45° field of view; 2212x1659; fundus photo
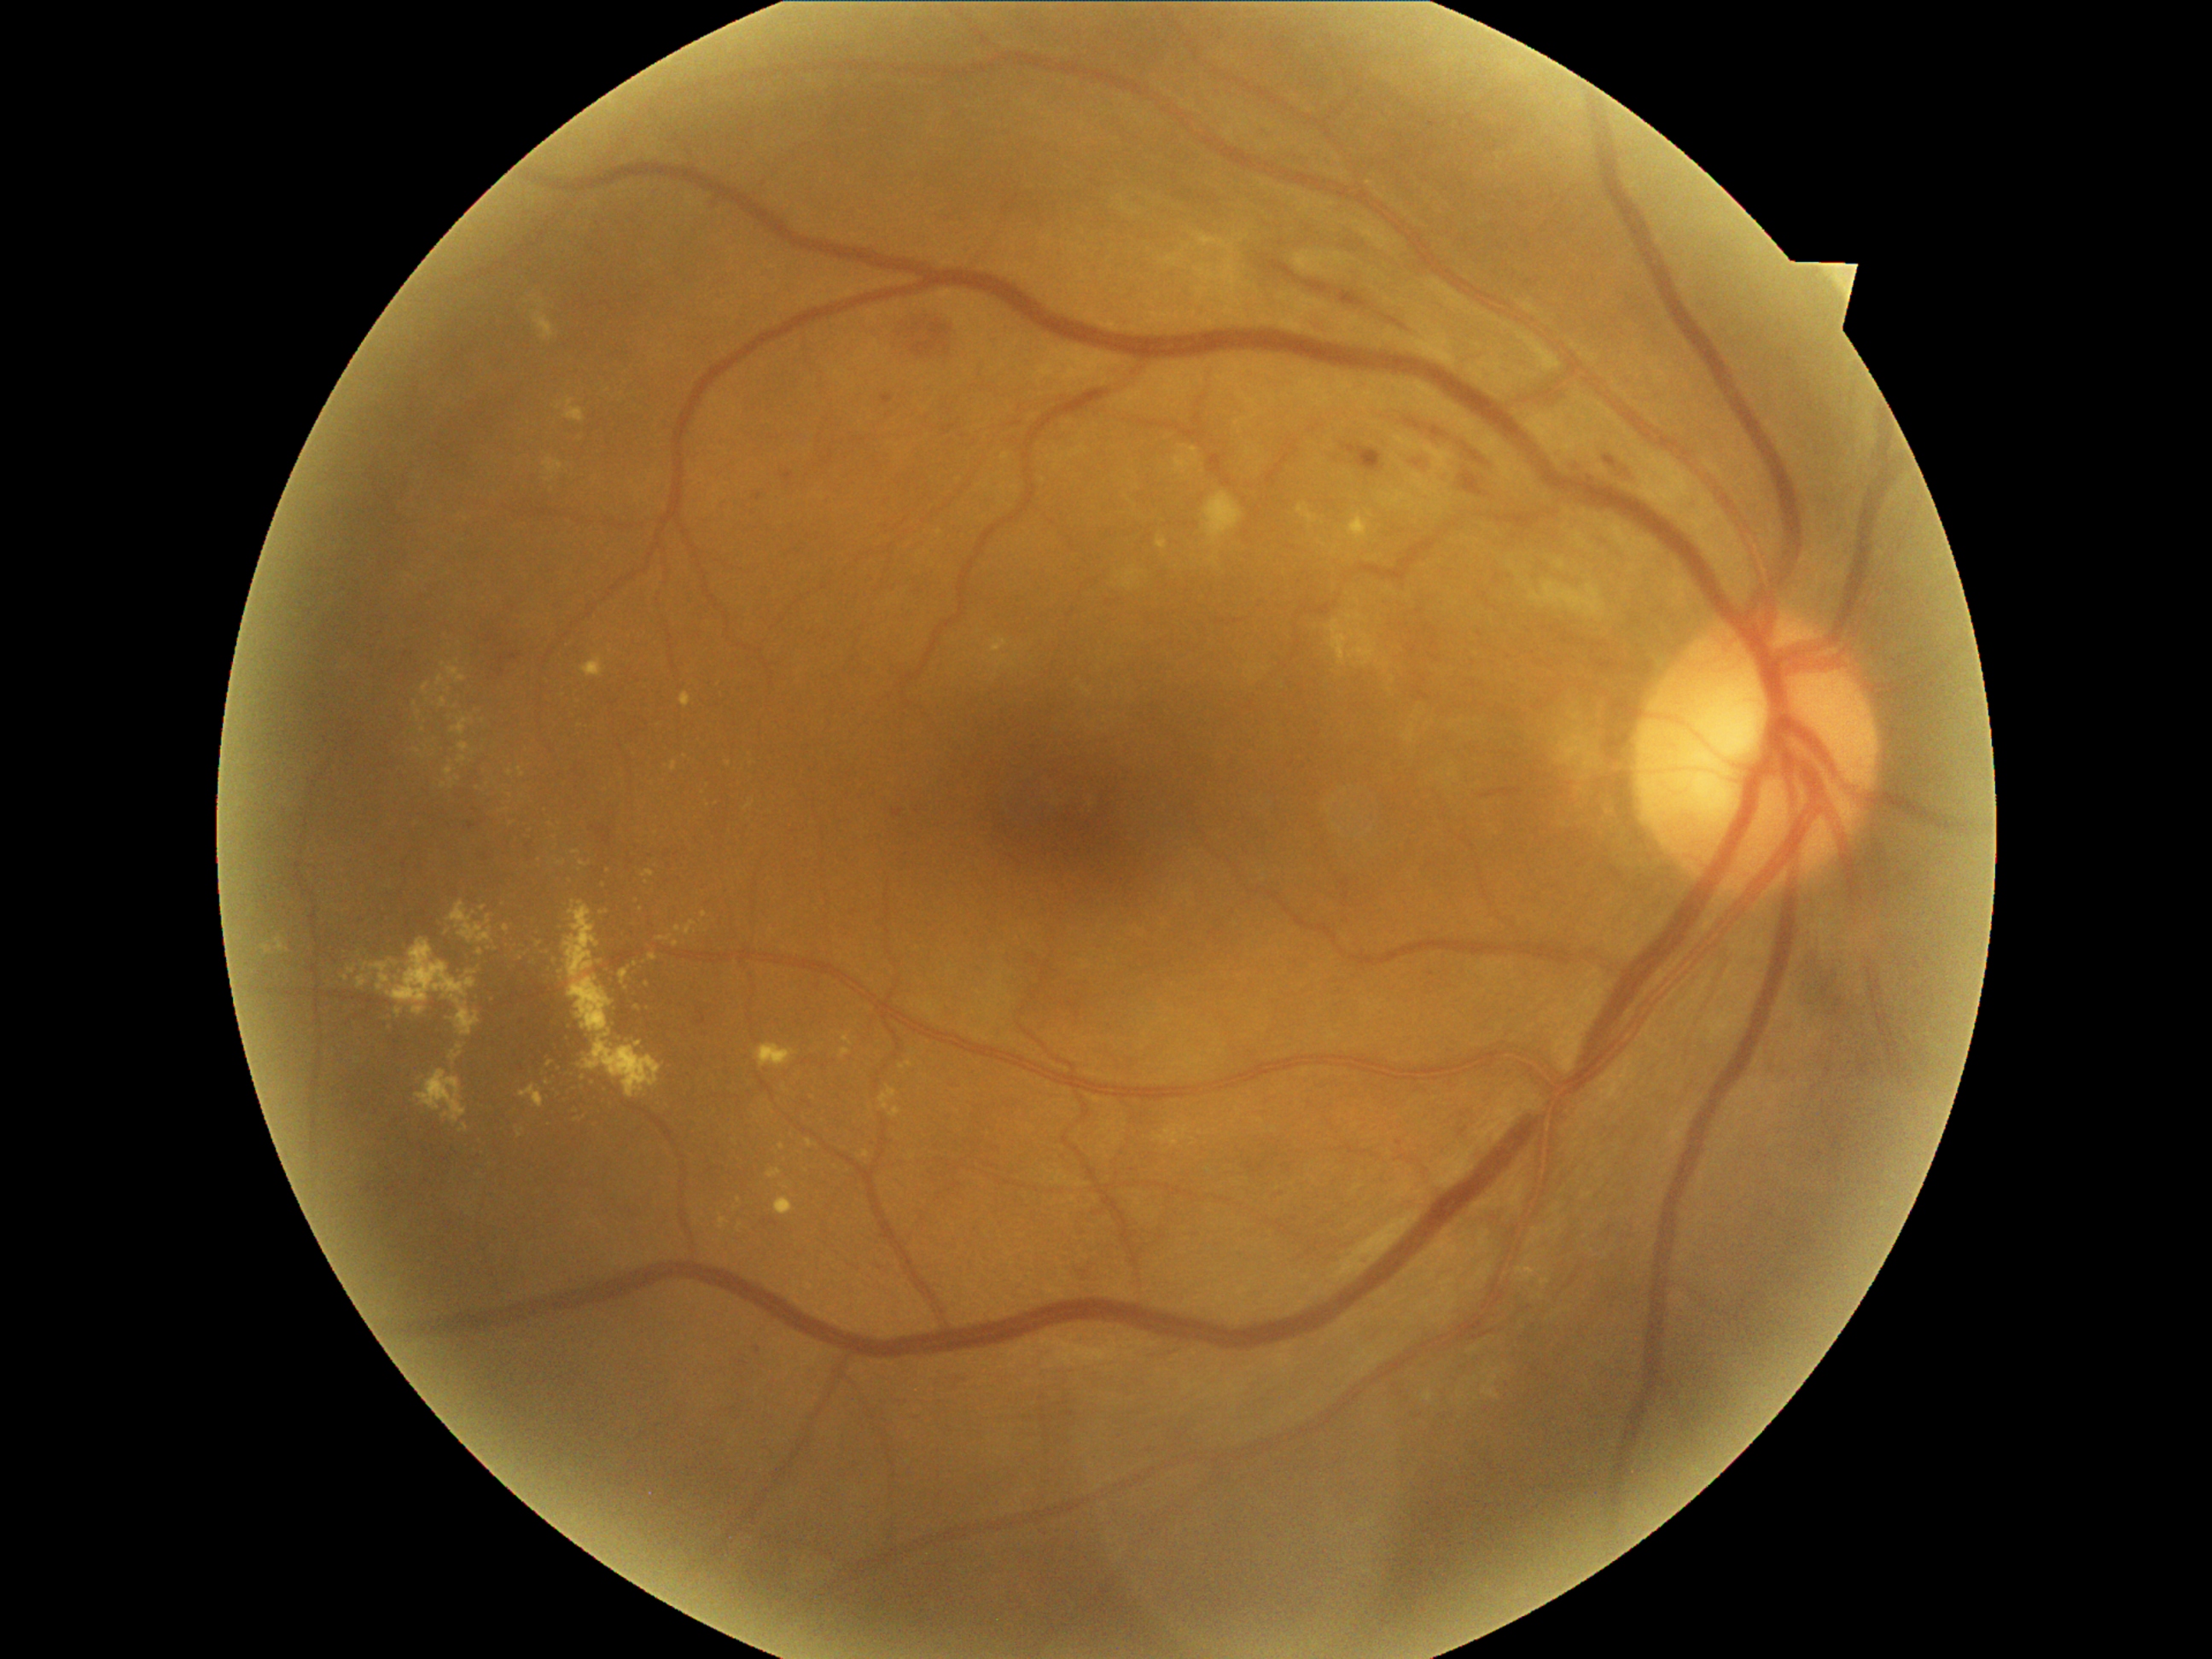
DR stage is moderate NPDR (grade 2).